Nonmydriatic. 45-degree field of view. Acquired with a NIDEK AFC-230. Graded on the modified Davis scale. Fundus photo: 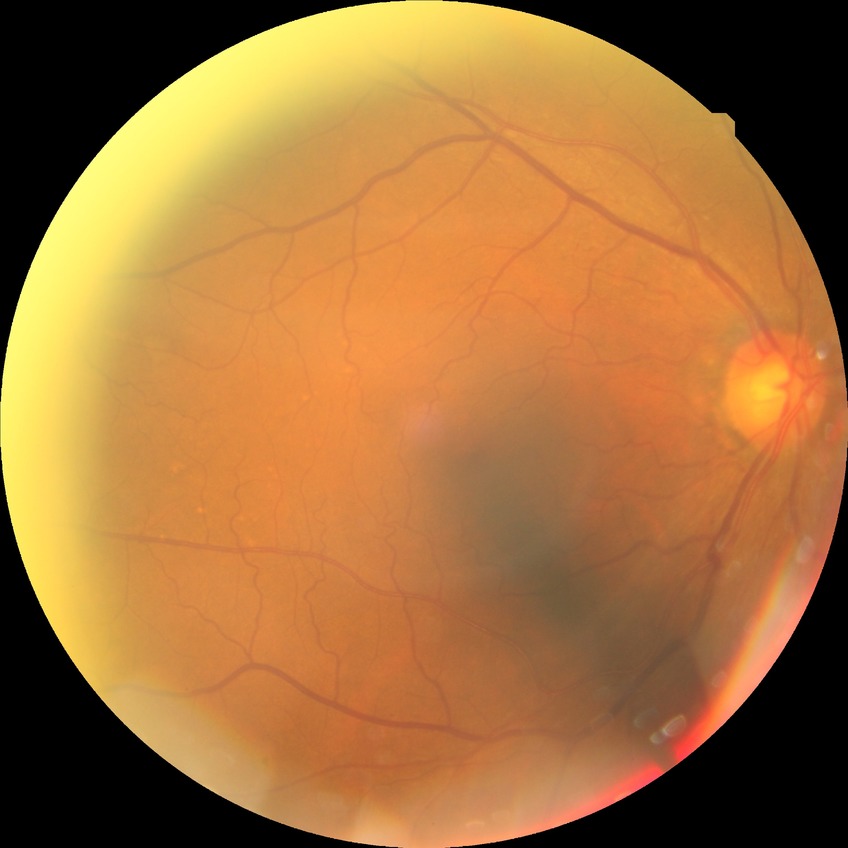
davis_grade: NDR
dr_impression: no signs of DR